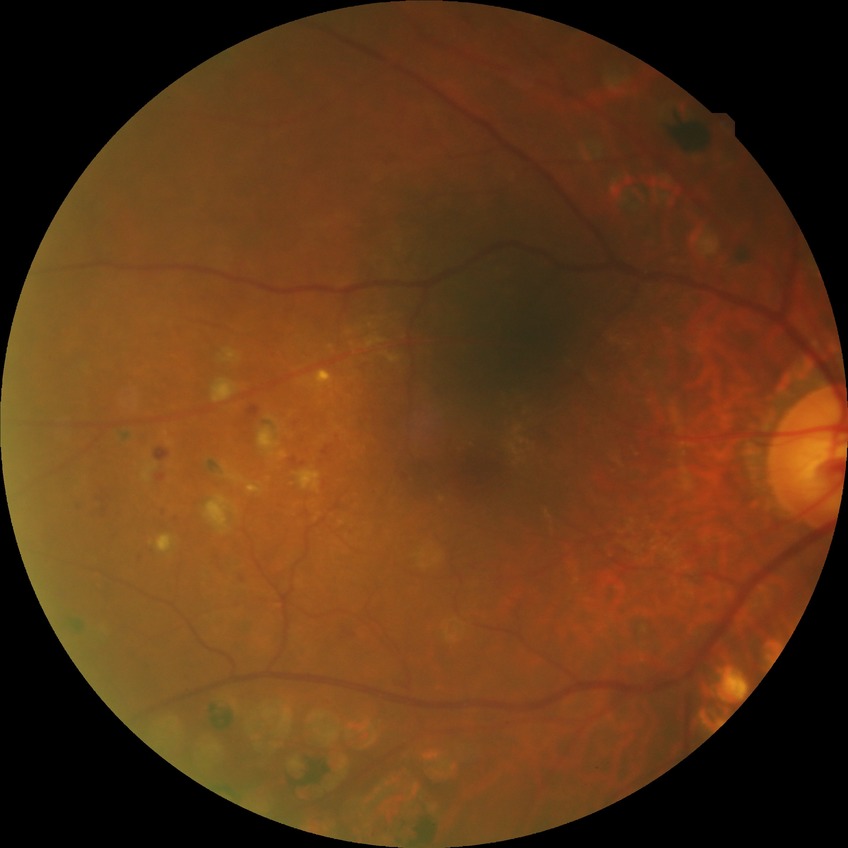

Diabetic retinopathy (DR) is proliferative diabetic retinopathy (PDR).